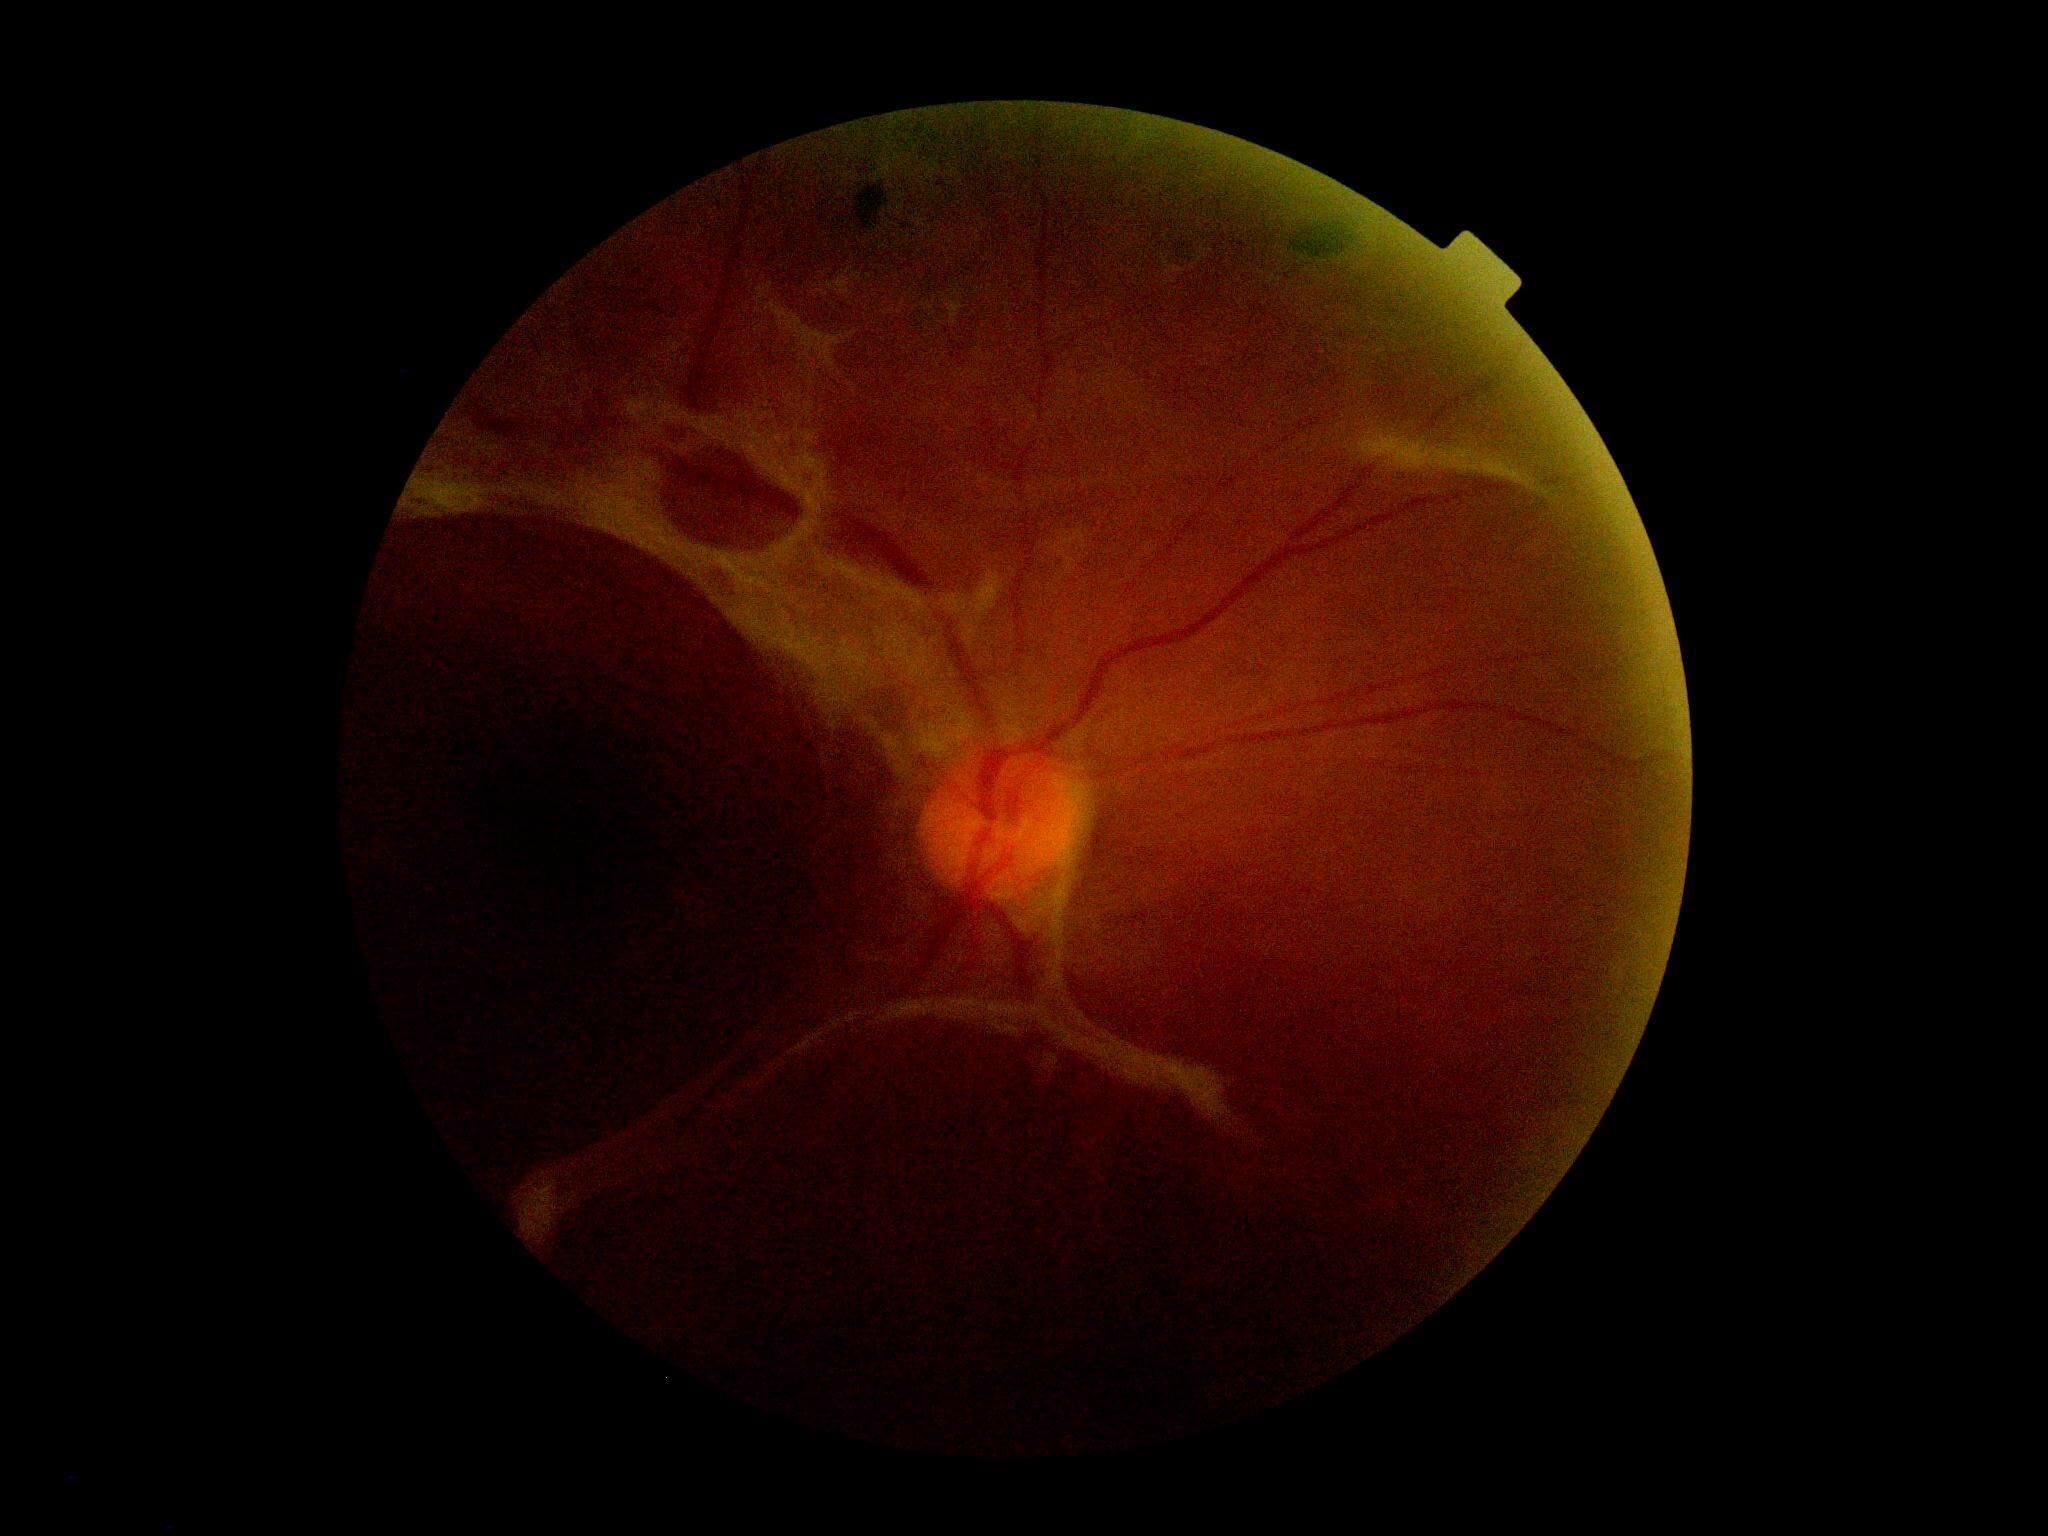

Retinopathy grade: proliferative diabetic retinopathy (4). Disease class: proliferative diabetic retinopathy.